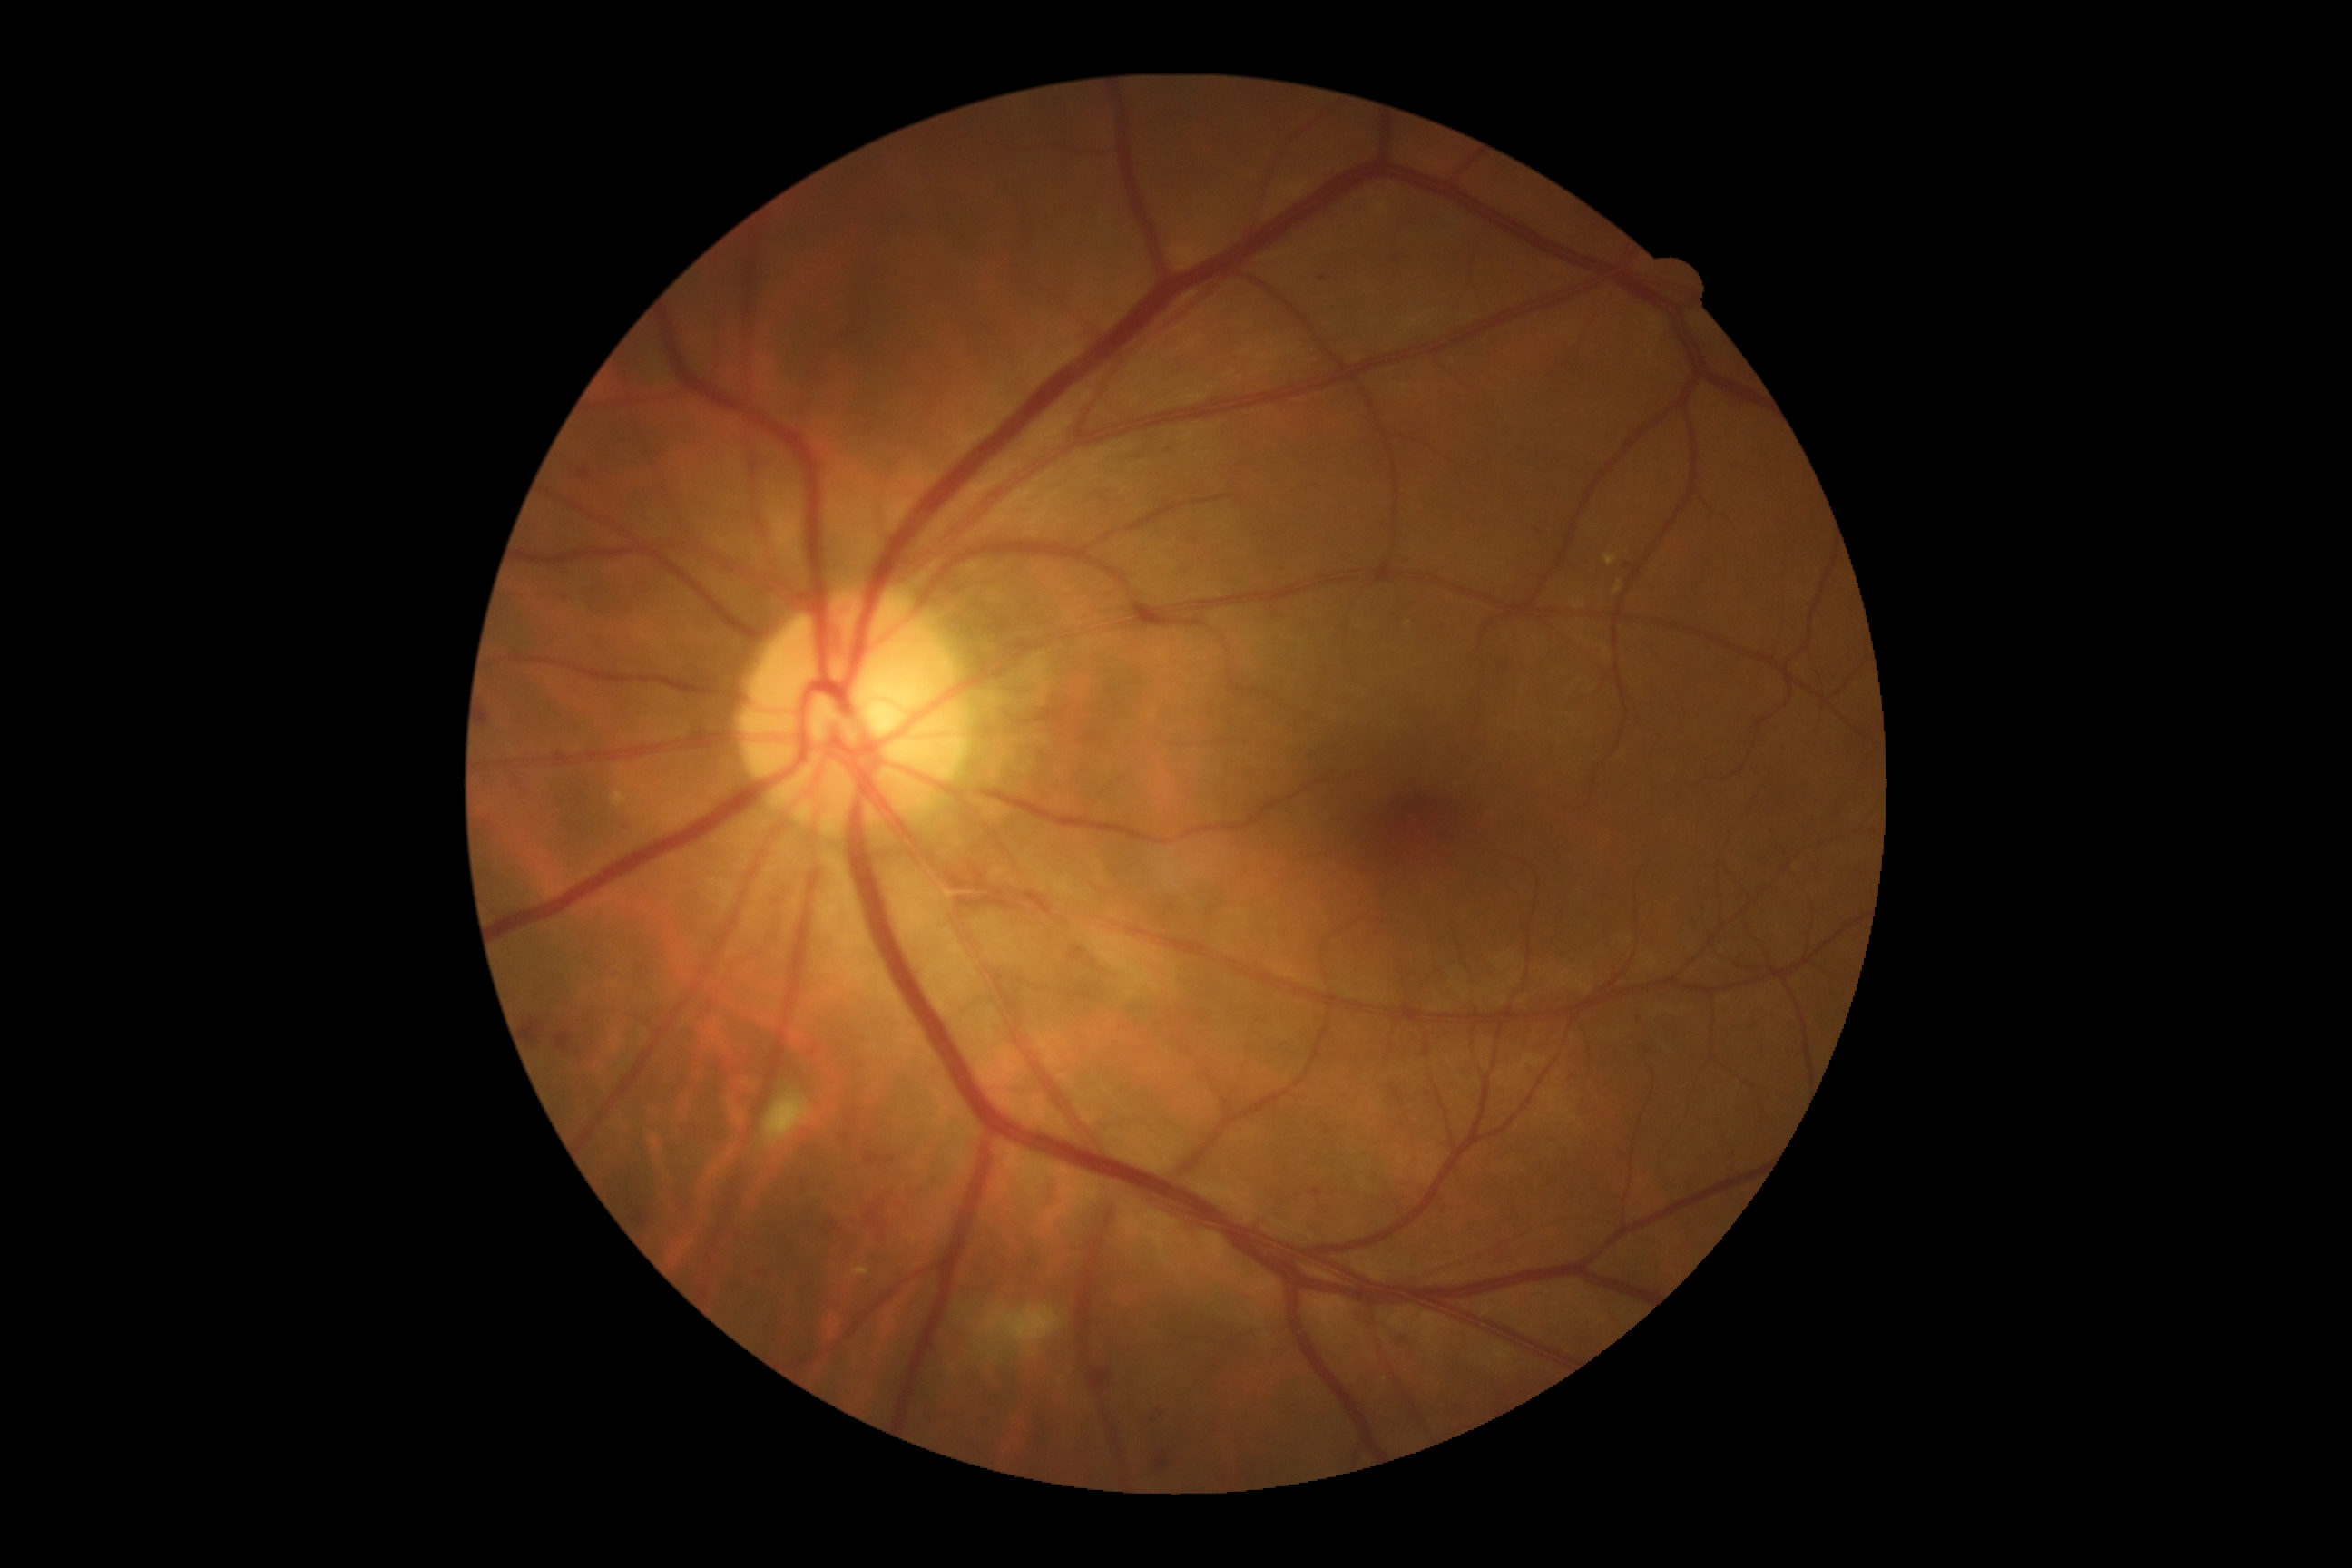 {"dr_grade": "2"}